45° field of view — 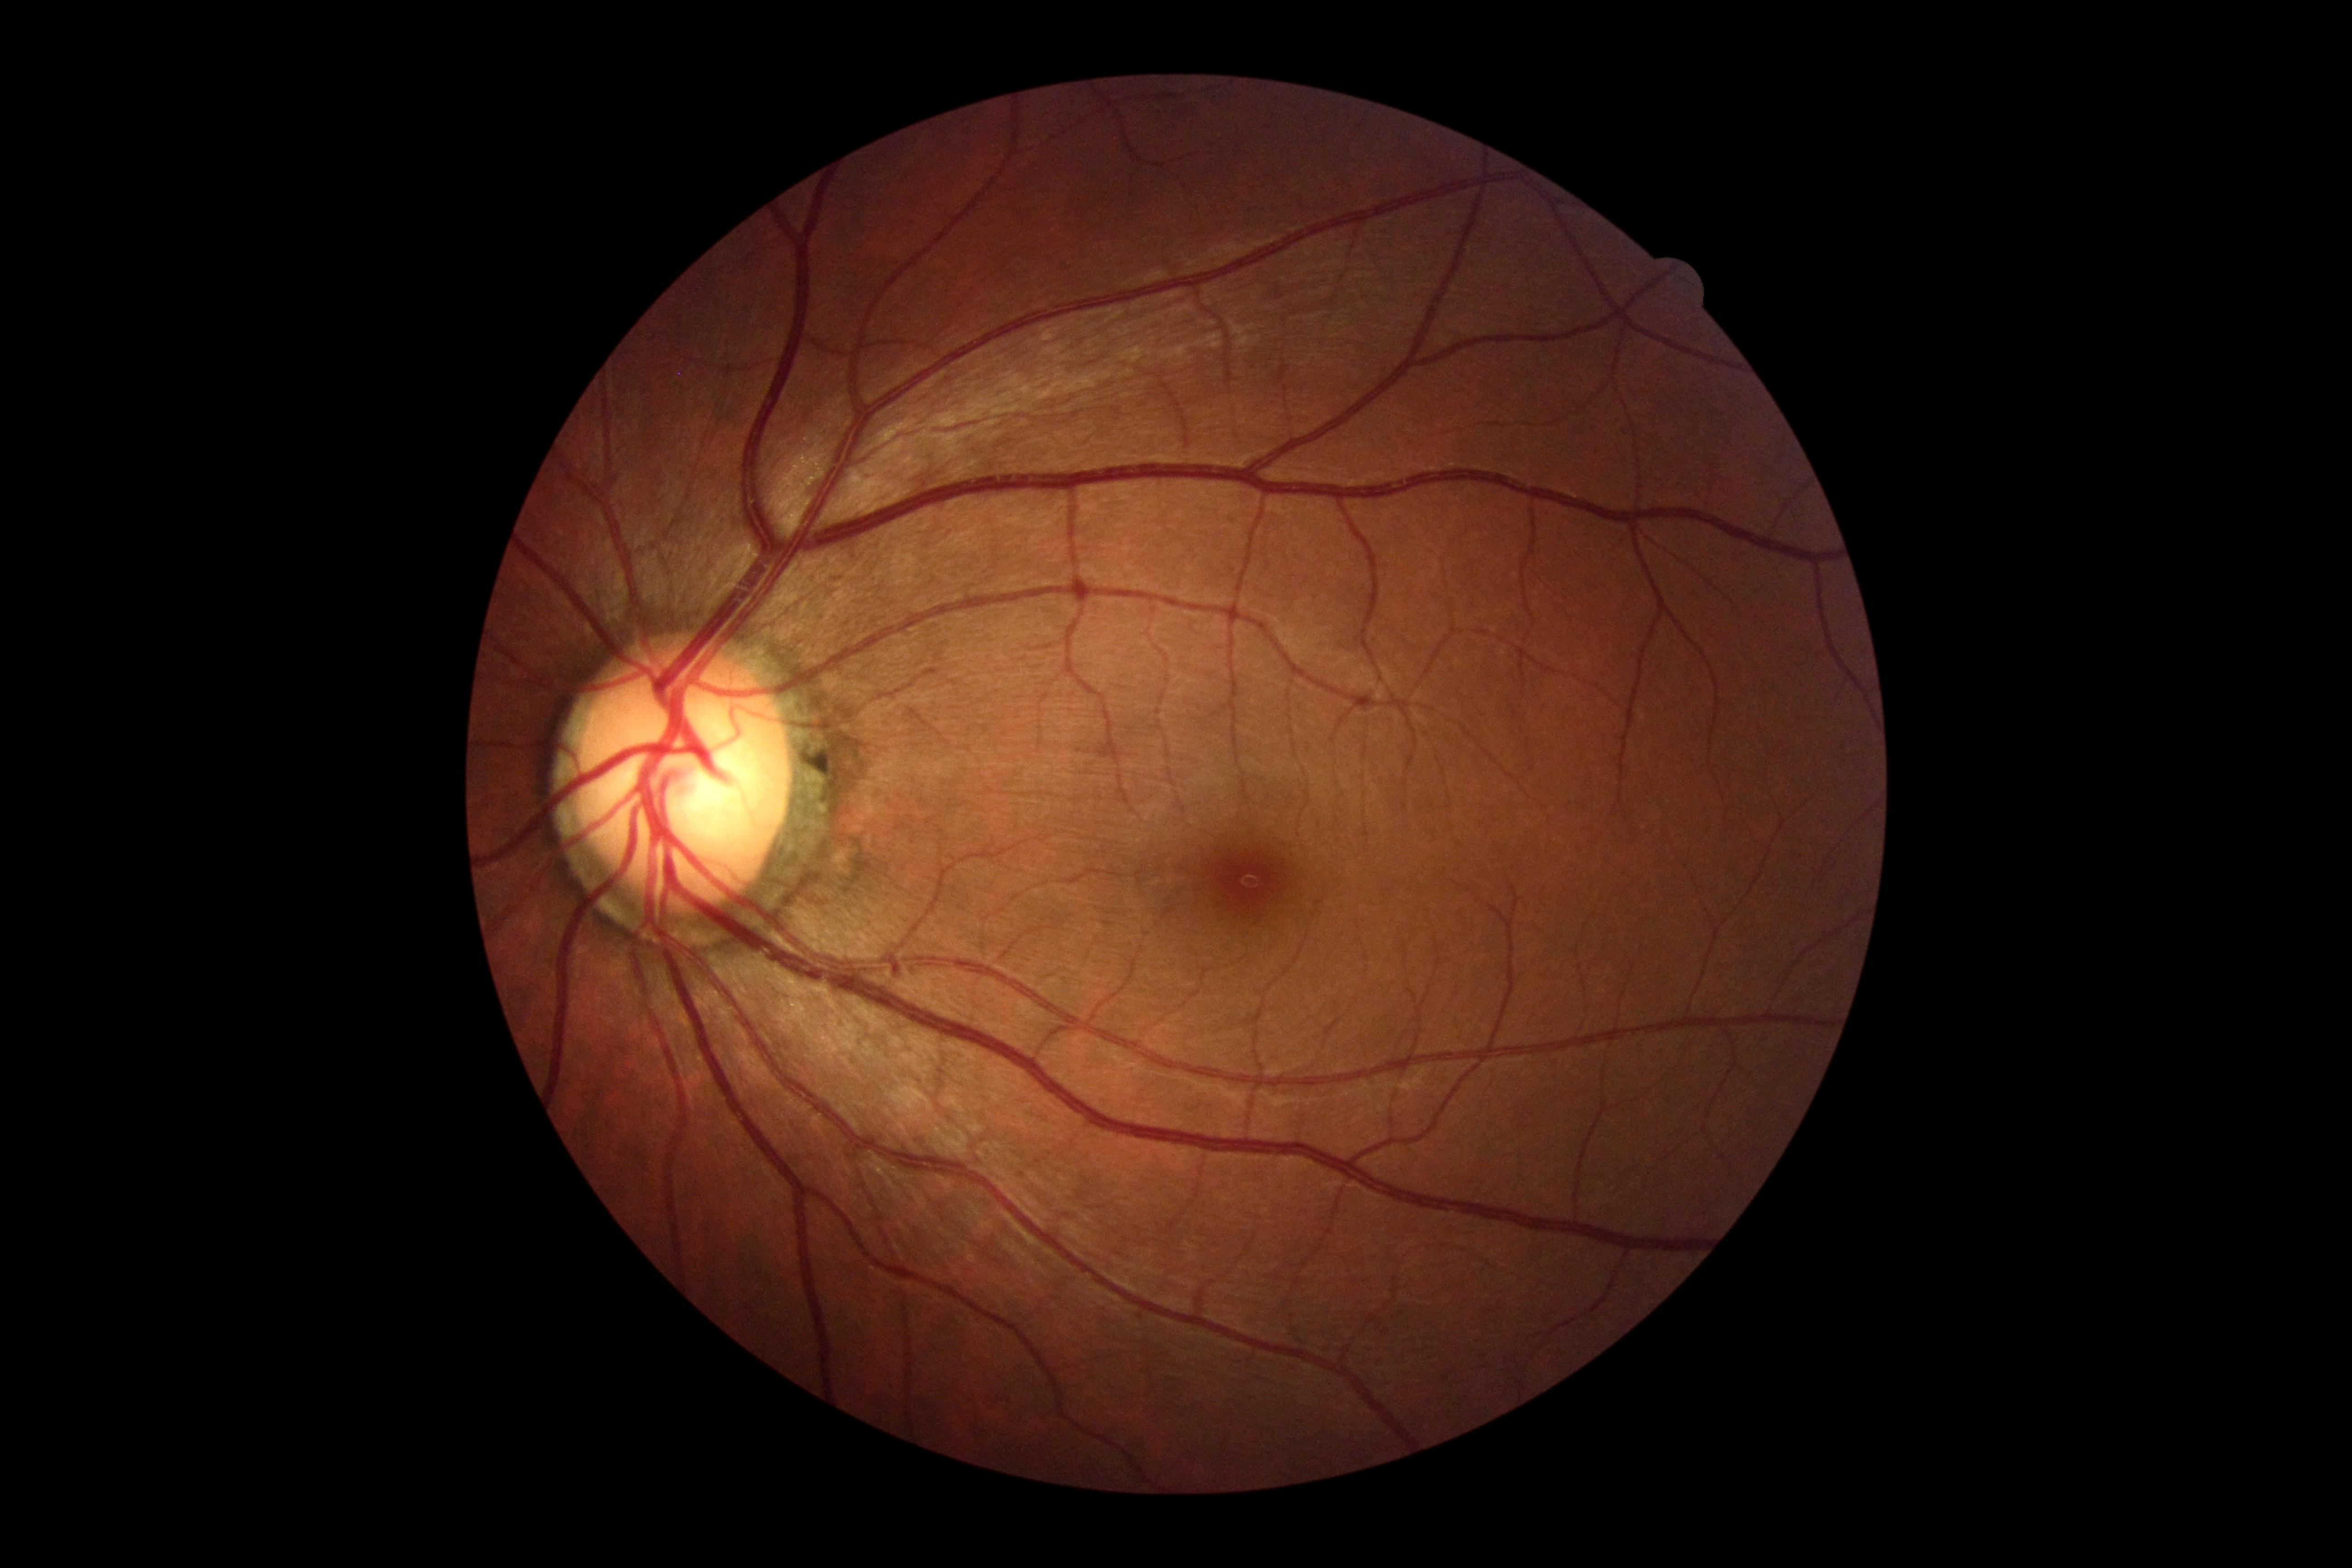

Retinopathy grade is 0.